45° field of view; NIDEK AFC-230; nonmydriatic; diabetic retinopathy graded by the modified Davis classification; posterior pole photograph.
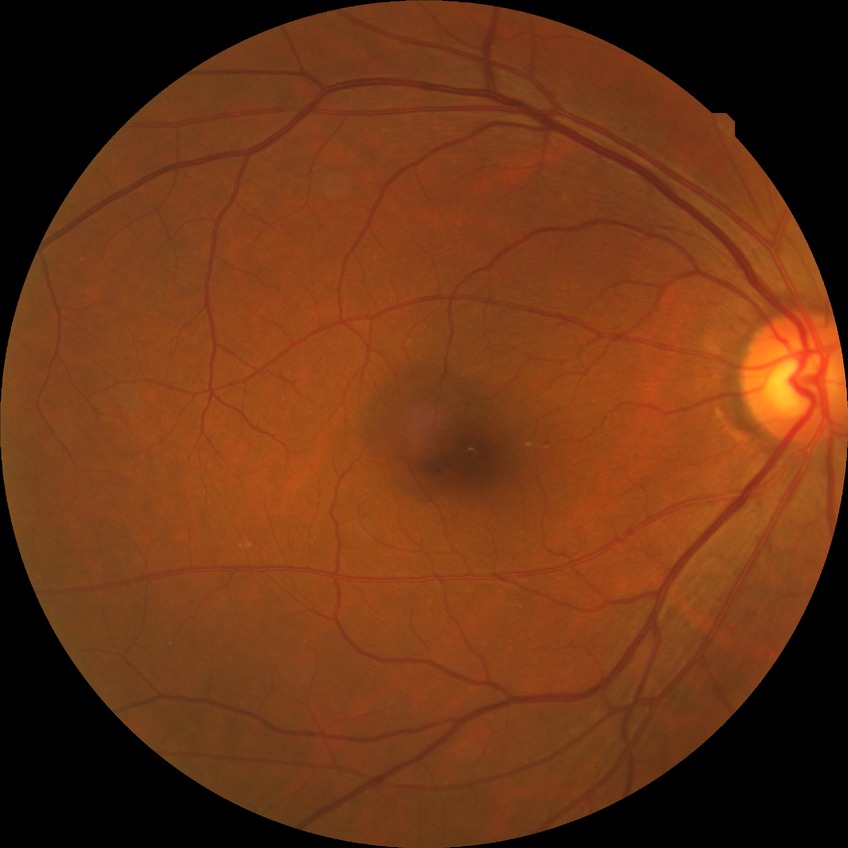 Retinopathy stage is simple diabetic retinopathy.